Retinal fundus photograph, 45-degree field of view:
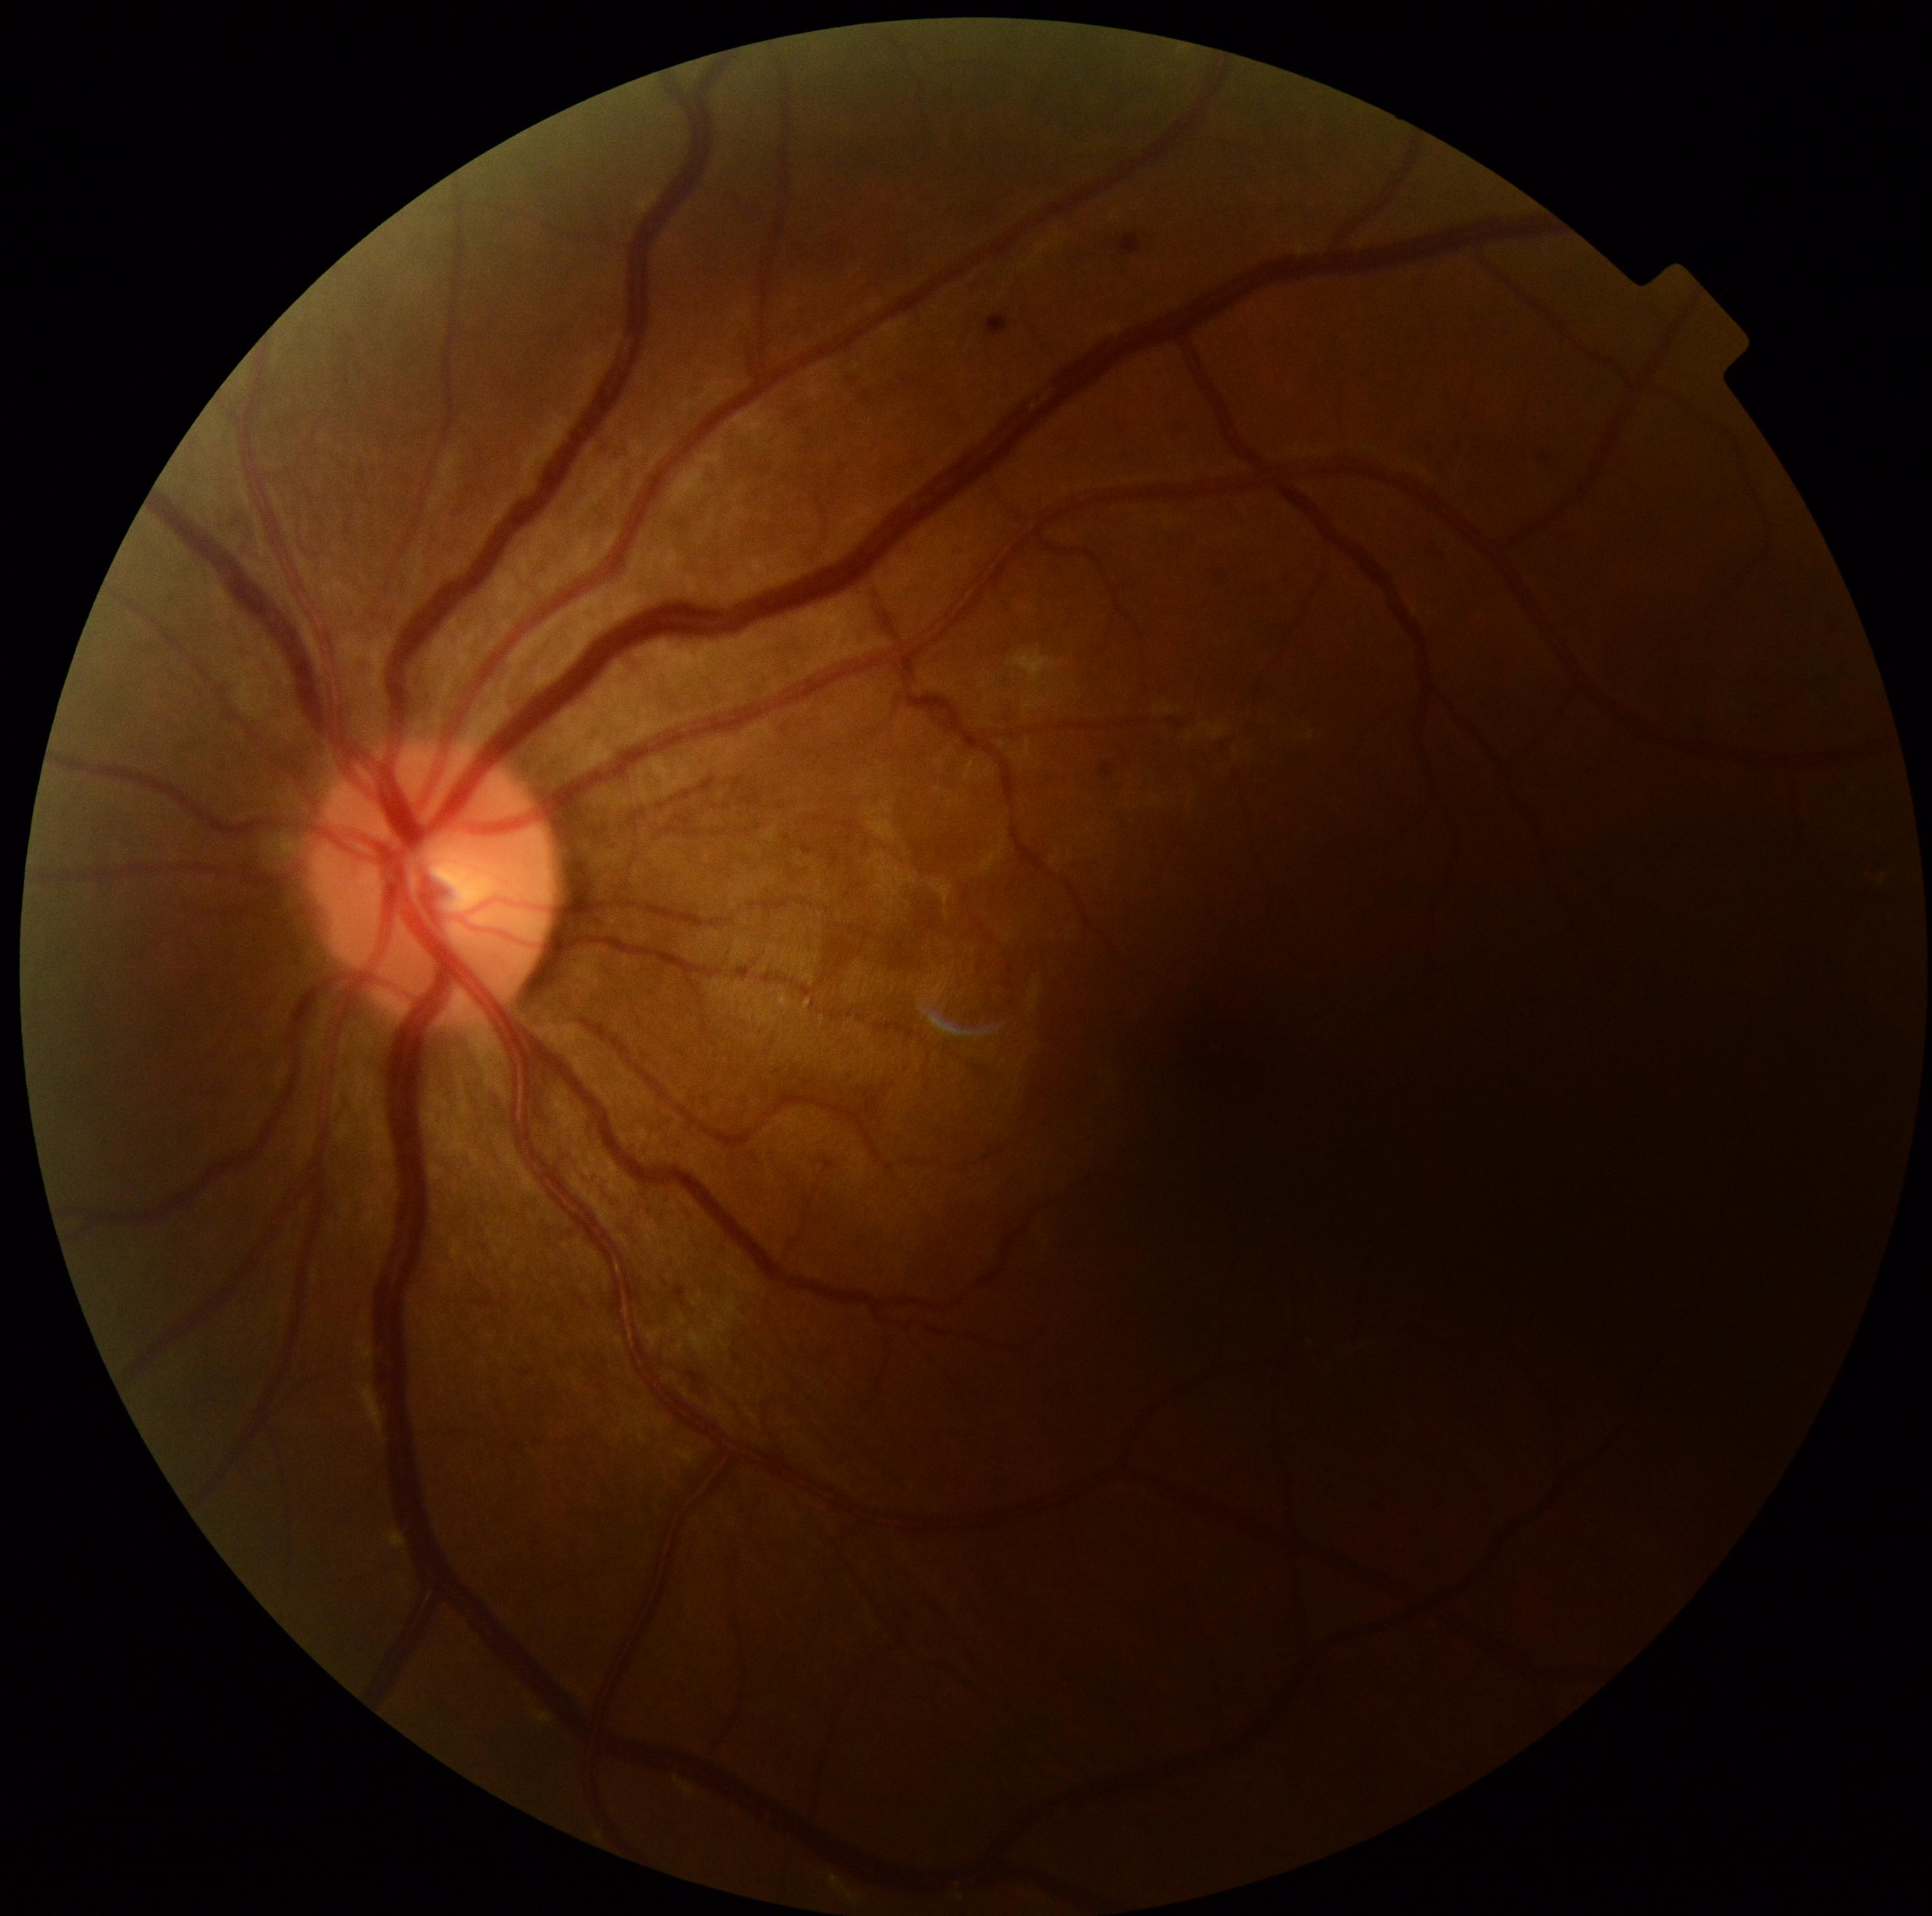

  dr_category: non-proliferative diabetic retinopathy
  dr_grade: 2